FOV: 45 degrees; 1536 x 1152 pixels — 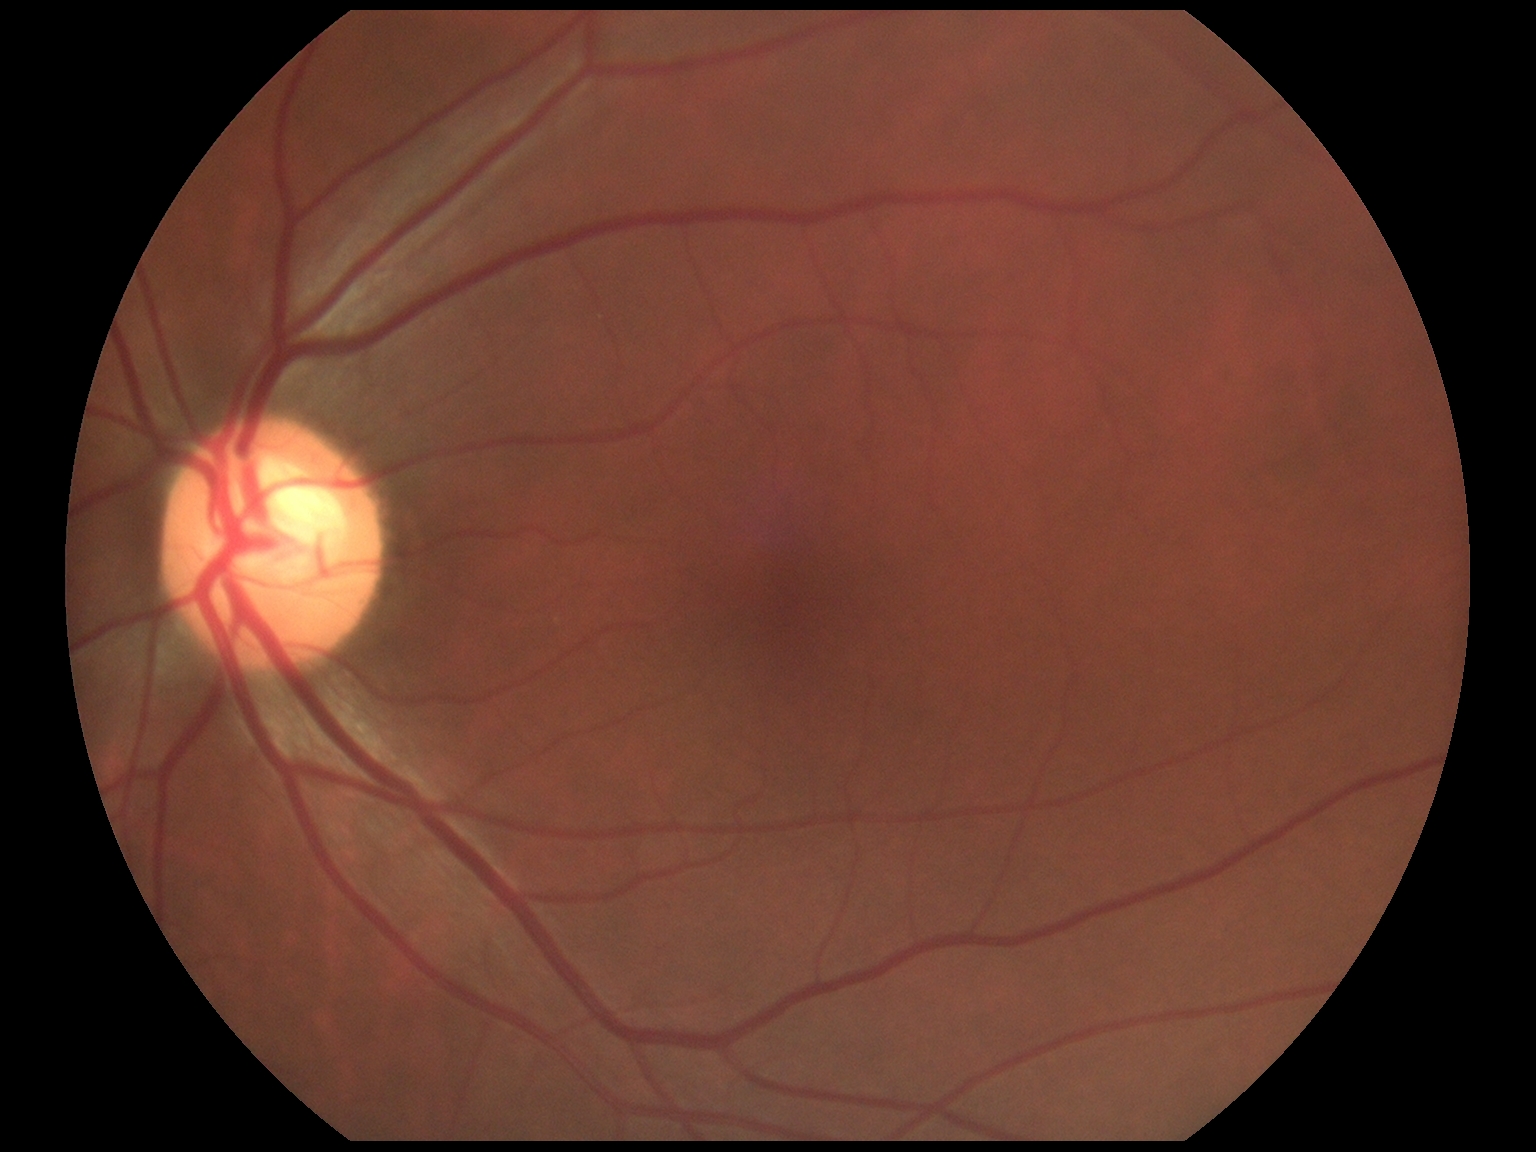   dr_grade: 0/4